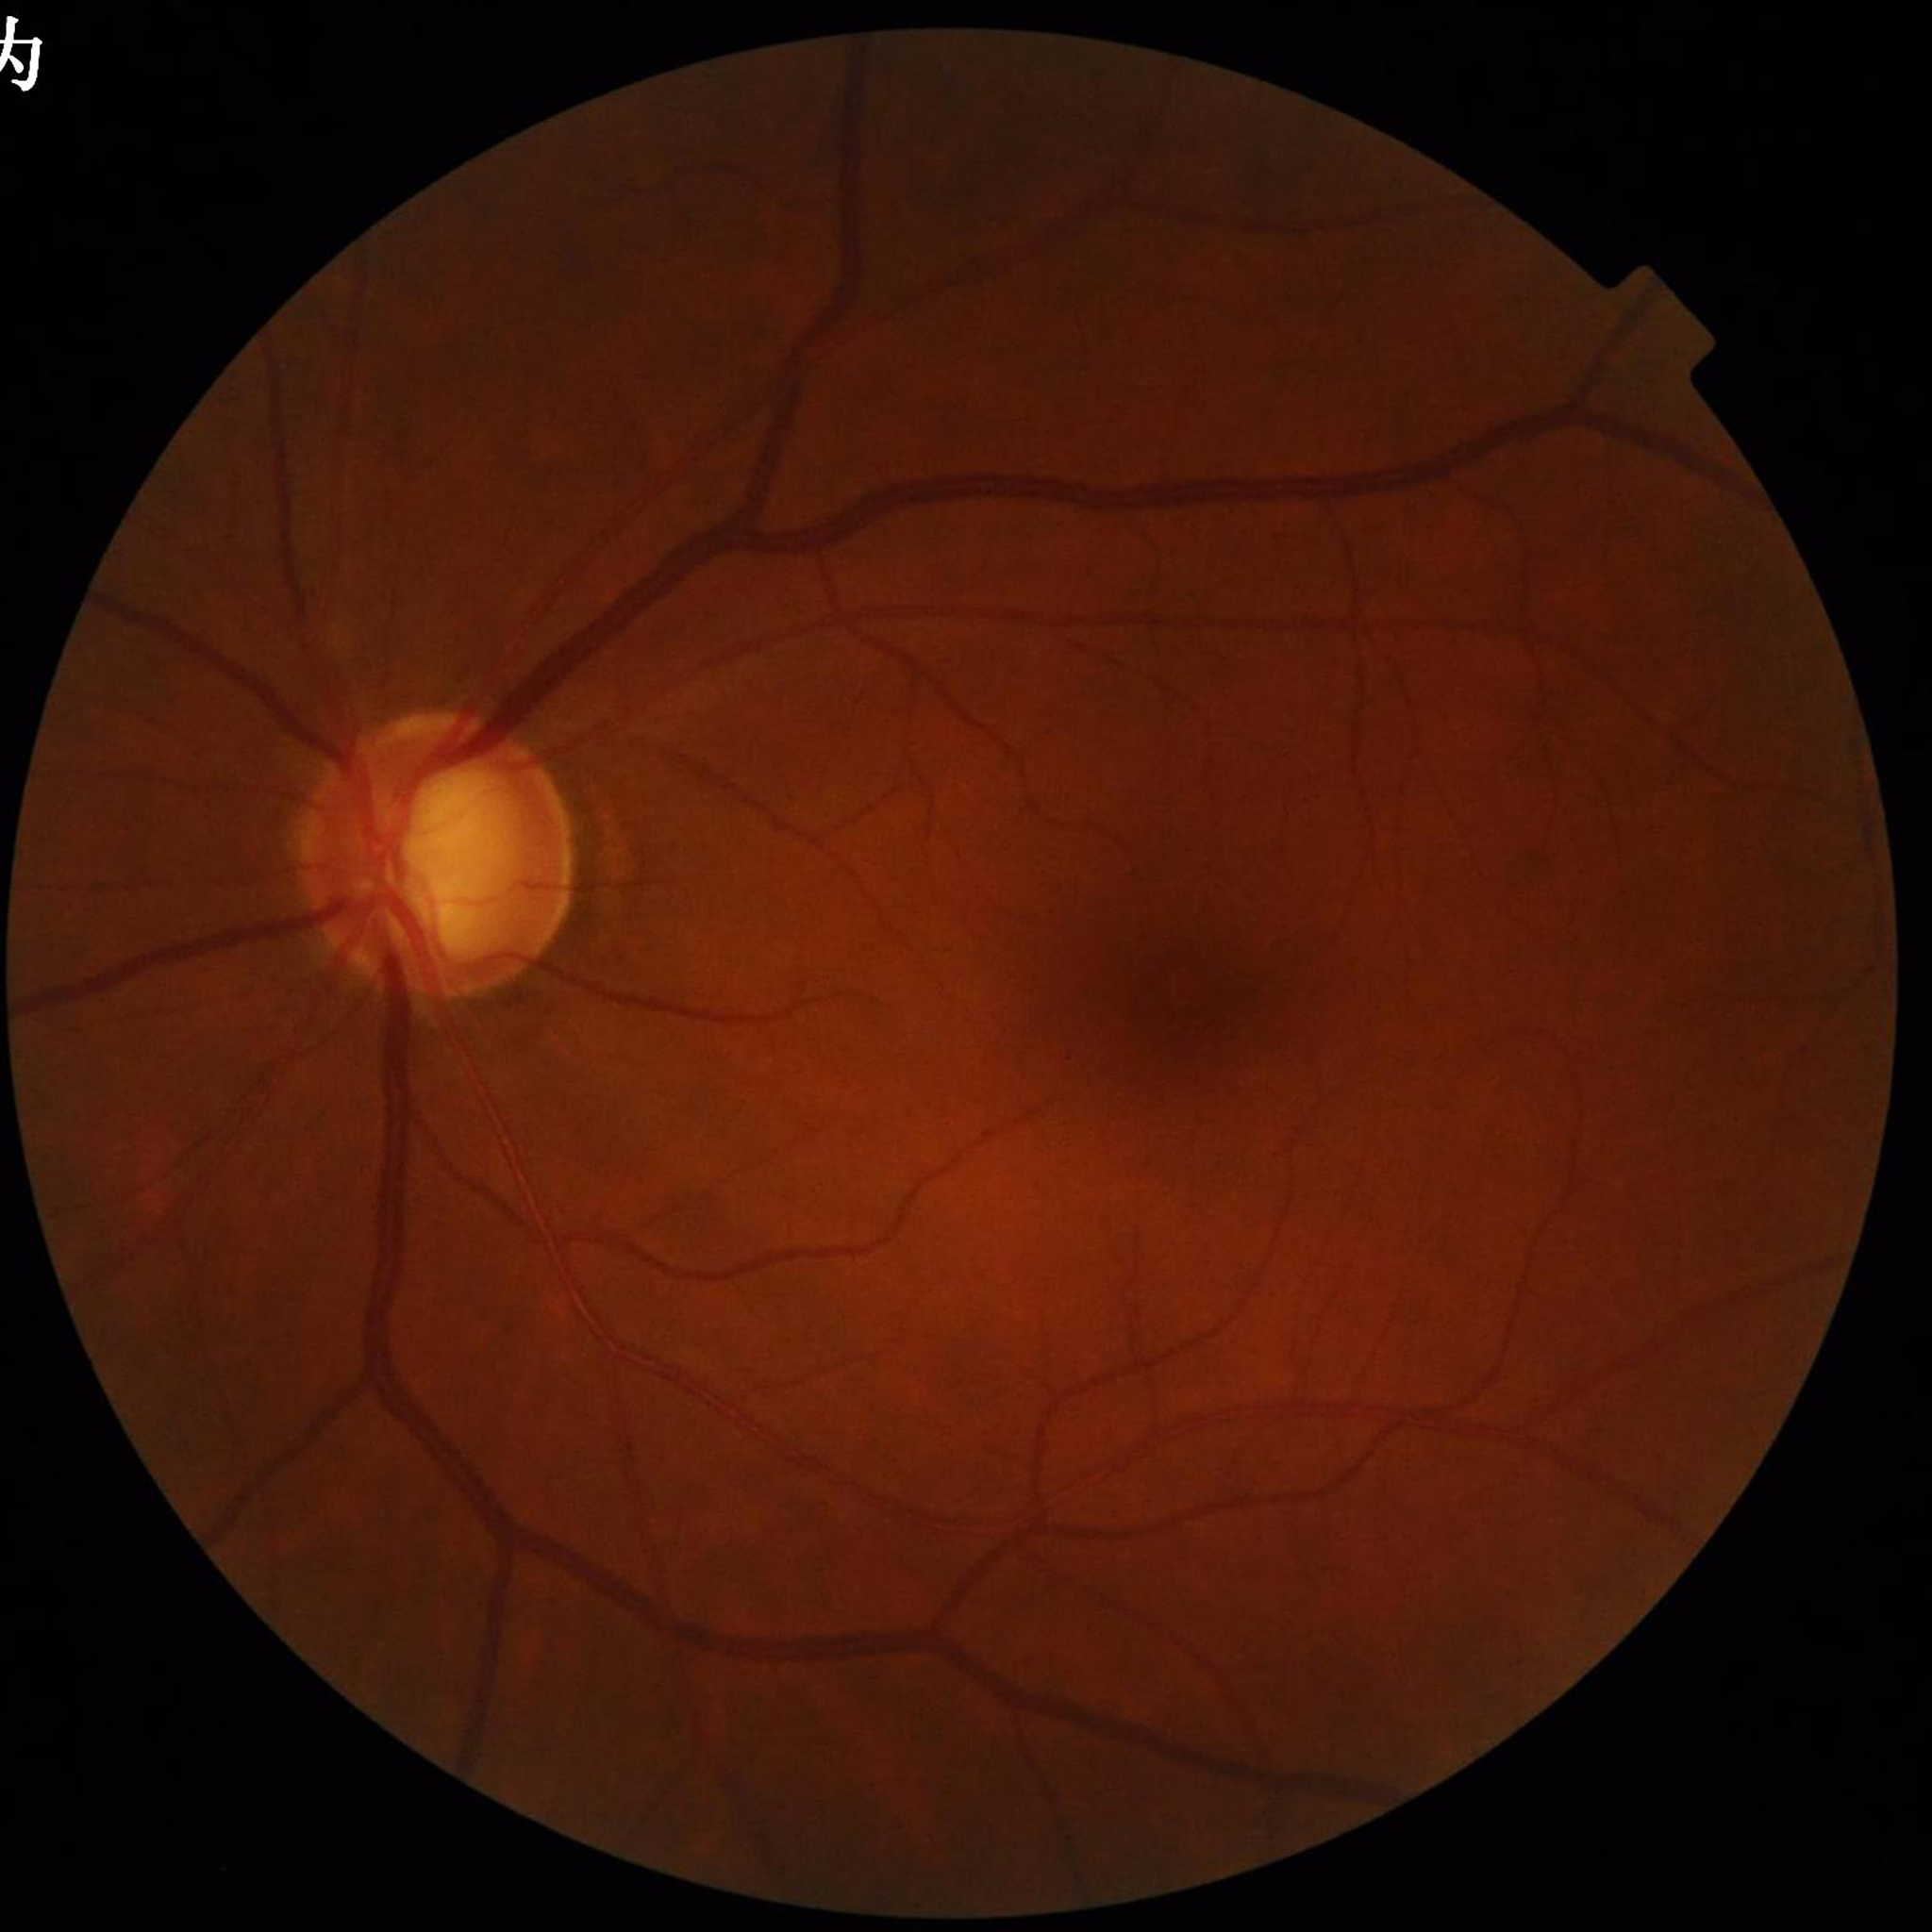
Fundus image of an eye with glaucoma.